Camera: NIDEK AFC-230, no pharmacologic dilation, DR severity per modified Davis staging:
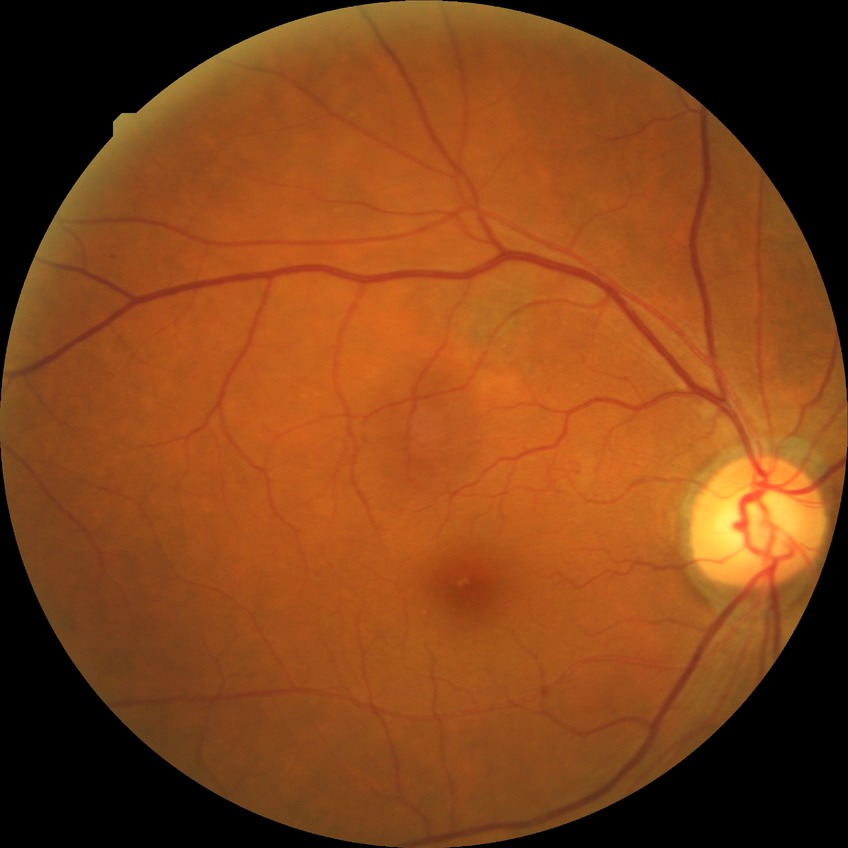
Diabetic retinopathy (DR) is simple diabetic retinopathy (SDR).